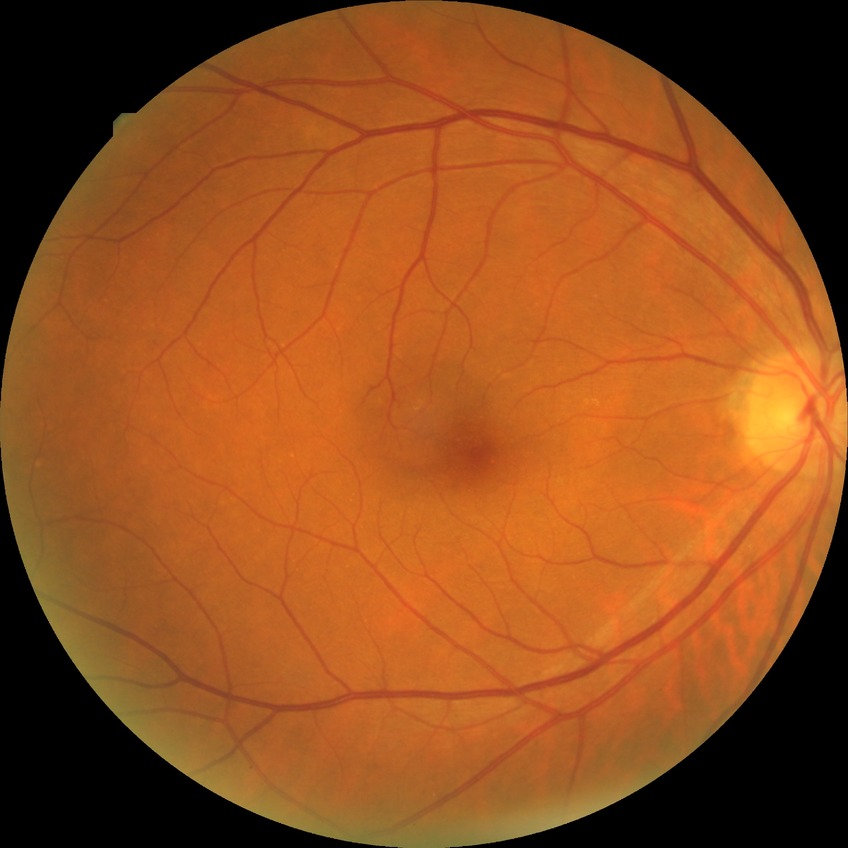

Davis grade@NDR, DR impression@no apparent DR.